848x848px · NIDEK AFC-230 · fundus photo · nonmydriatic.
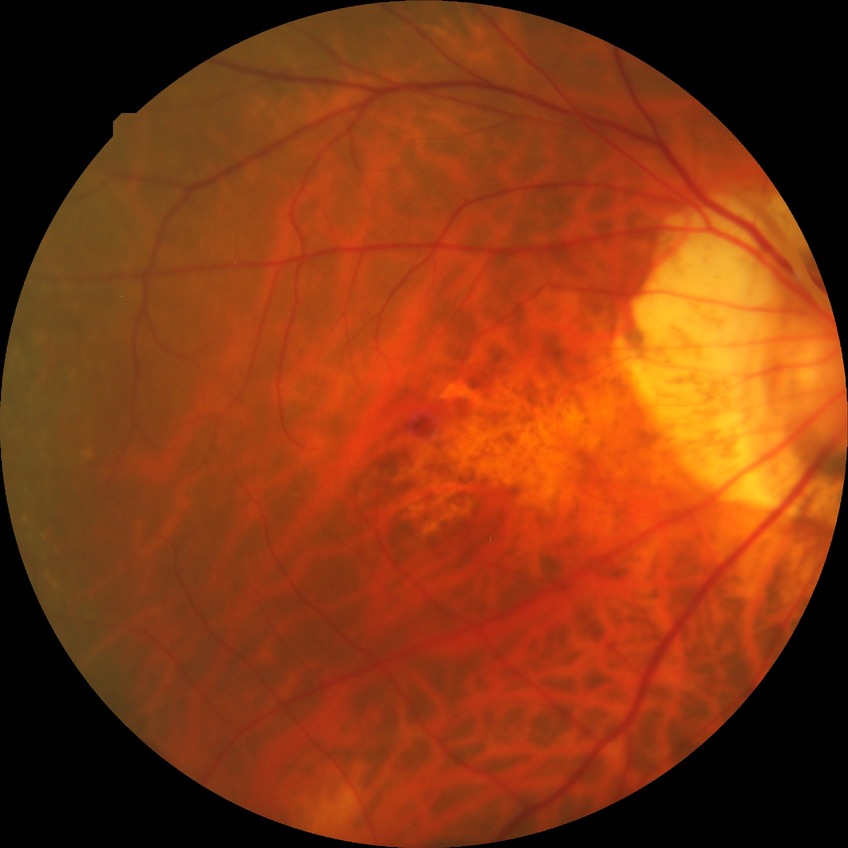 No DR findings. Davis stage is NDR.